Color fundus photograph; 45° field of view:
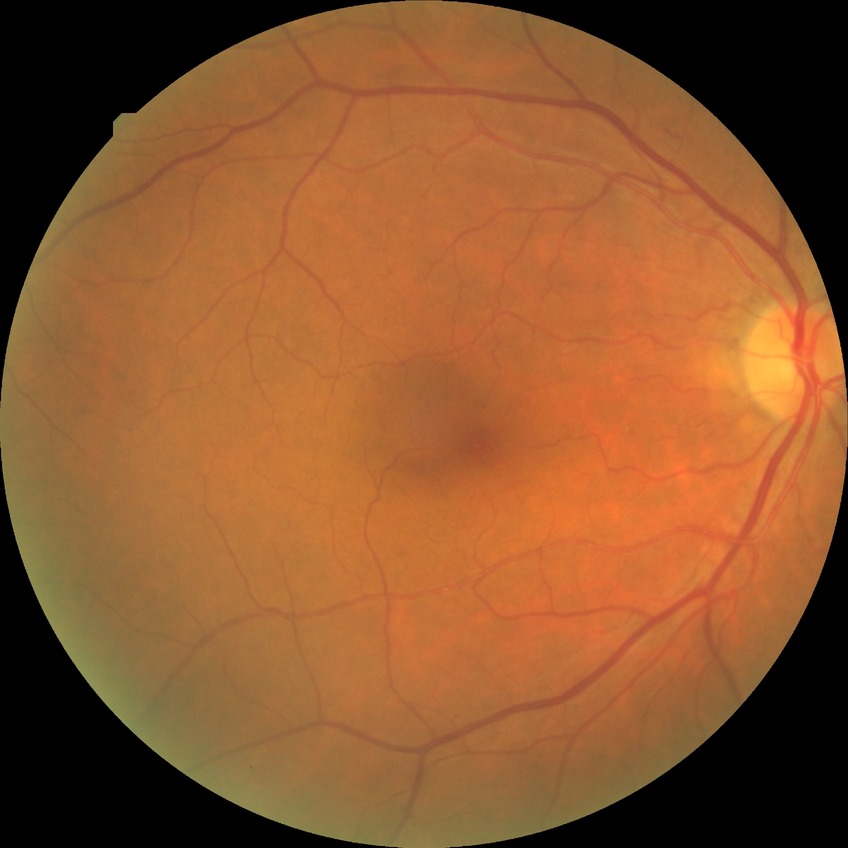

Diabetic retinopathy (DR) is no diabetic retinopathy (NDR).